Camera: NIDEK AFC-230; 45 degree fundus photograph; image size 848x848; nonmydriatic.
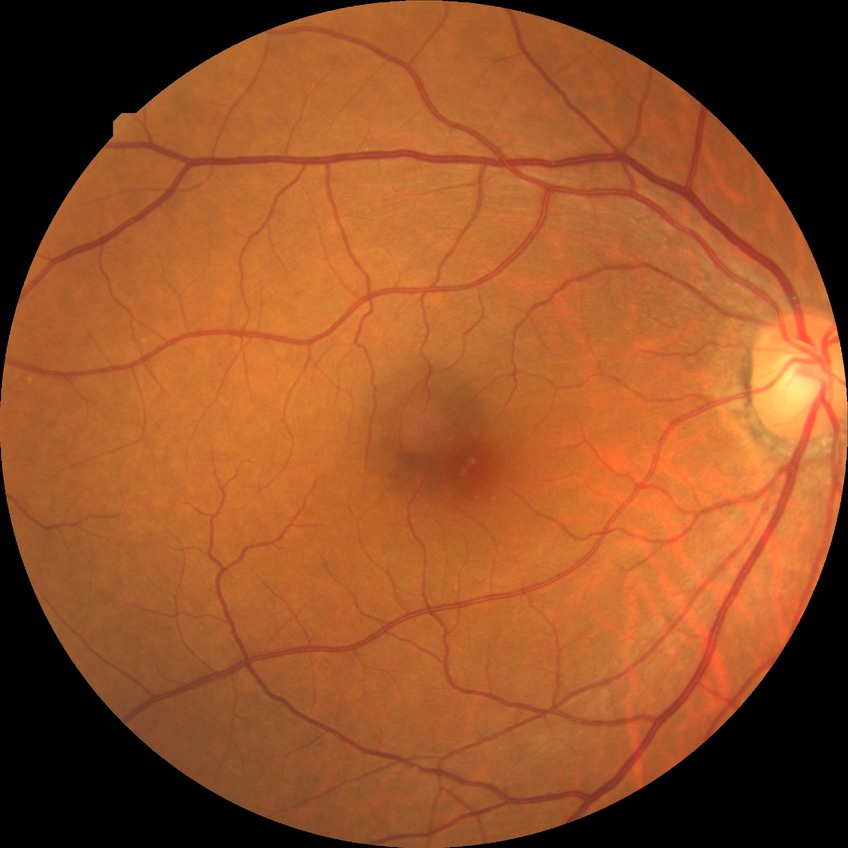
DR is NDR. No apparent diabetic retinopathy.